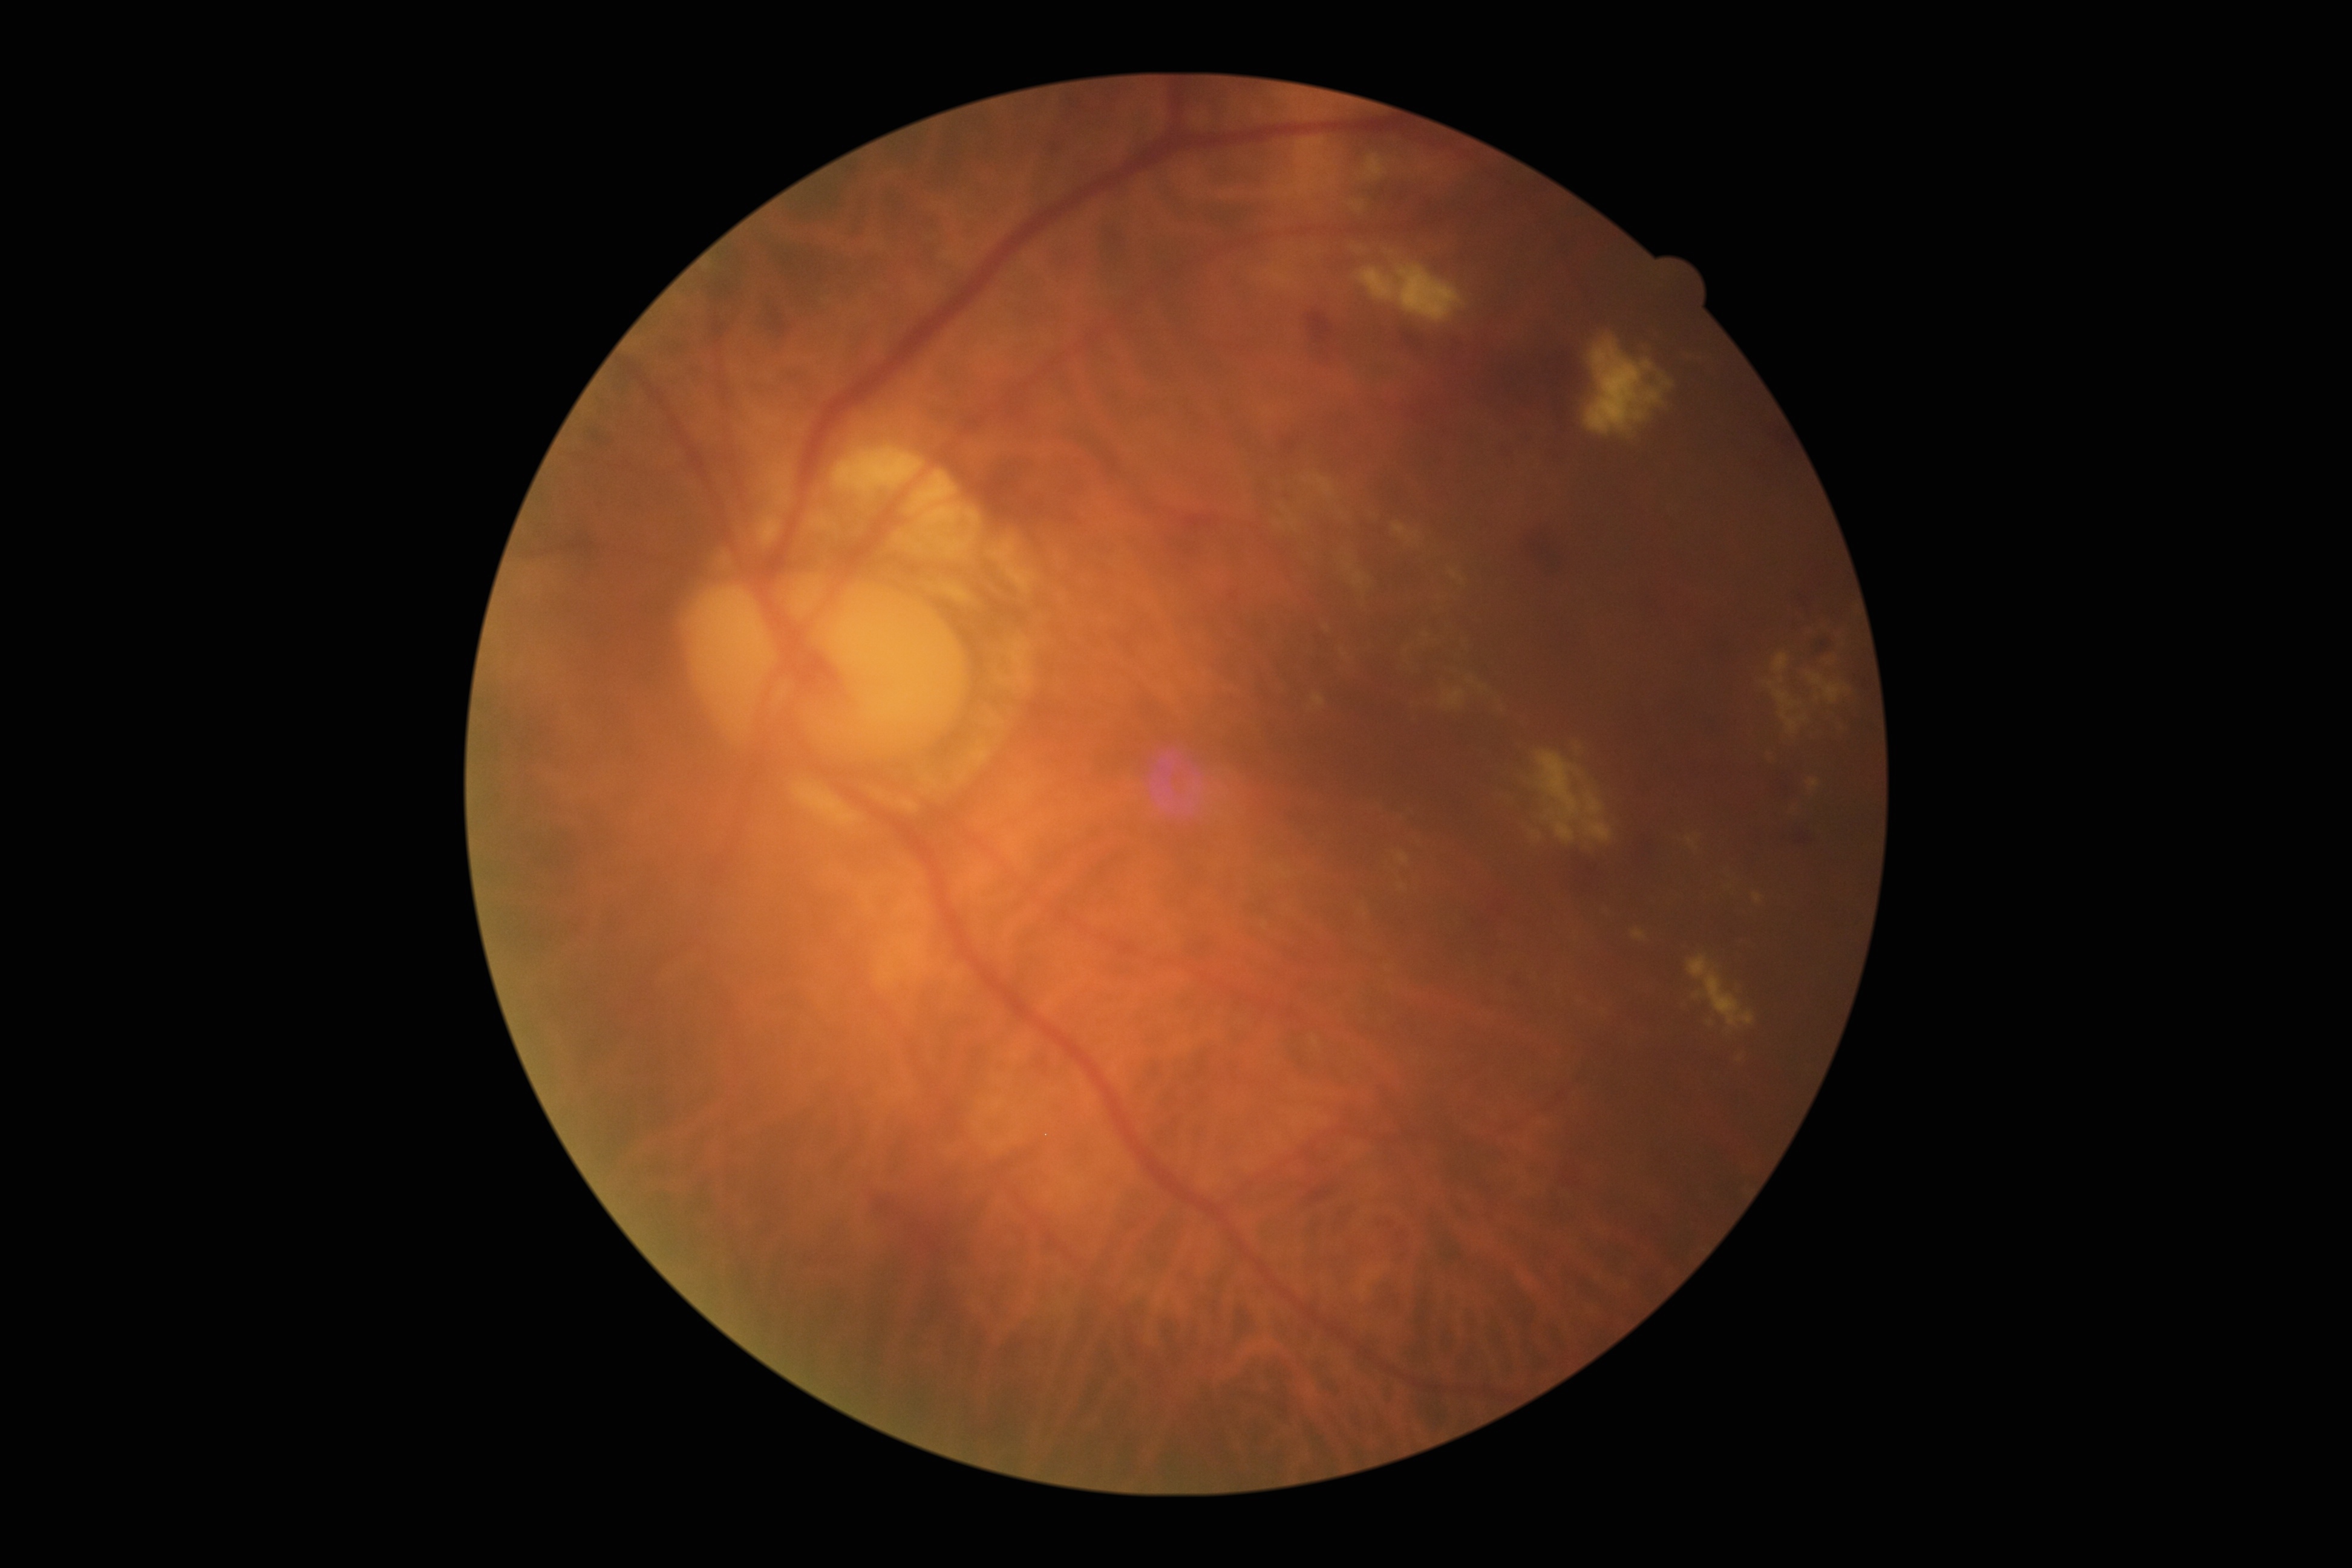
retinopathy grade@2.